Retinal fundus photograph — 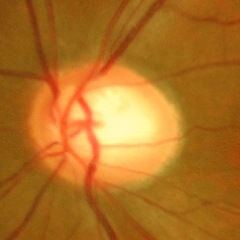
Demonstrates severe glaucomatous damage.